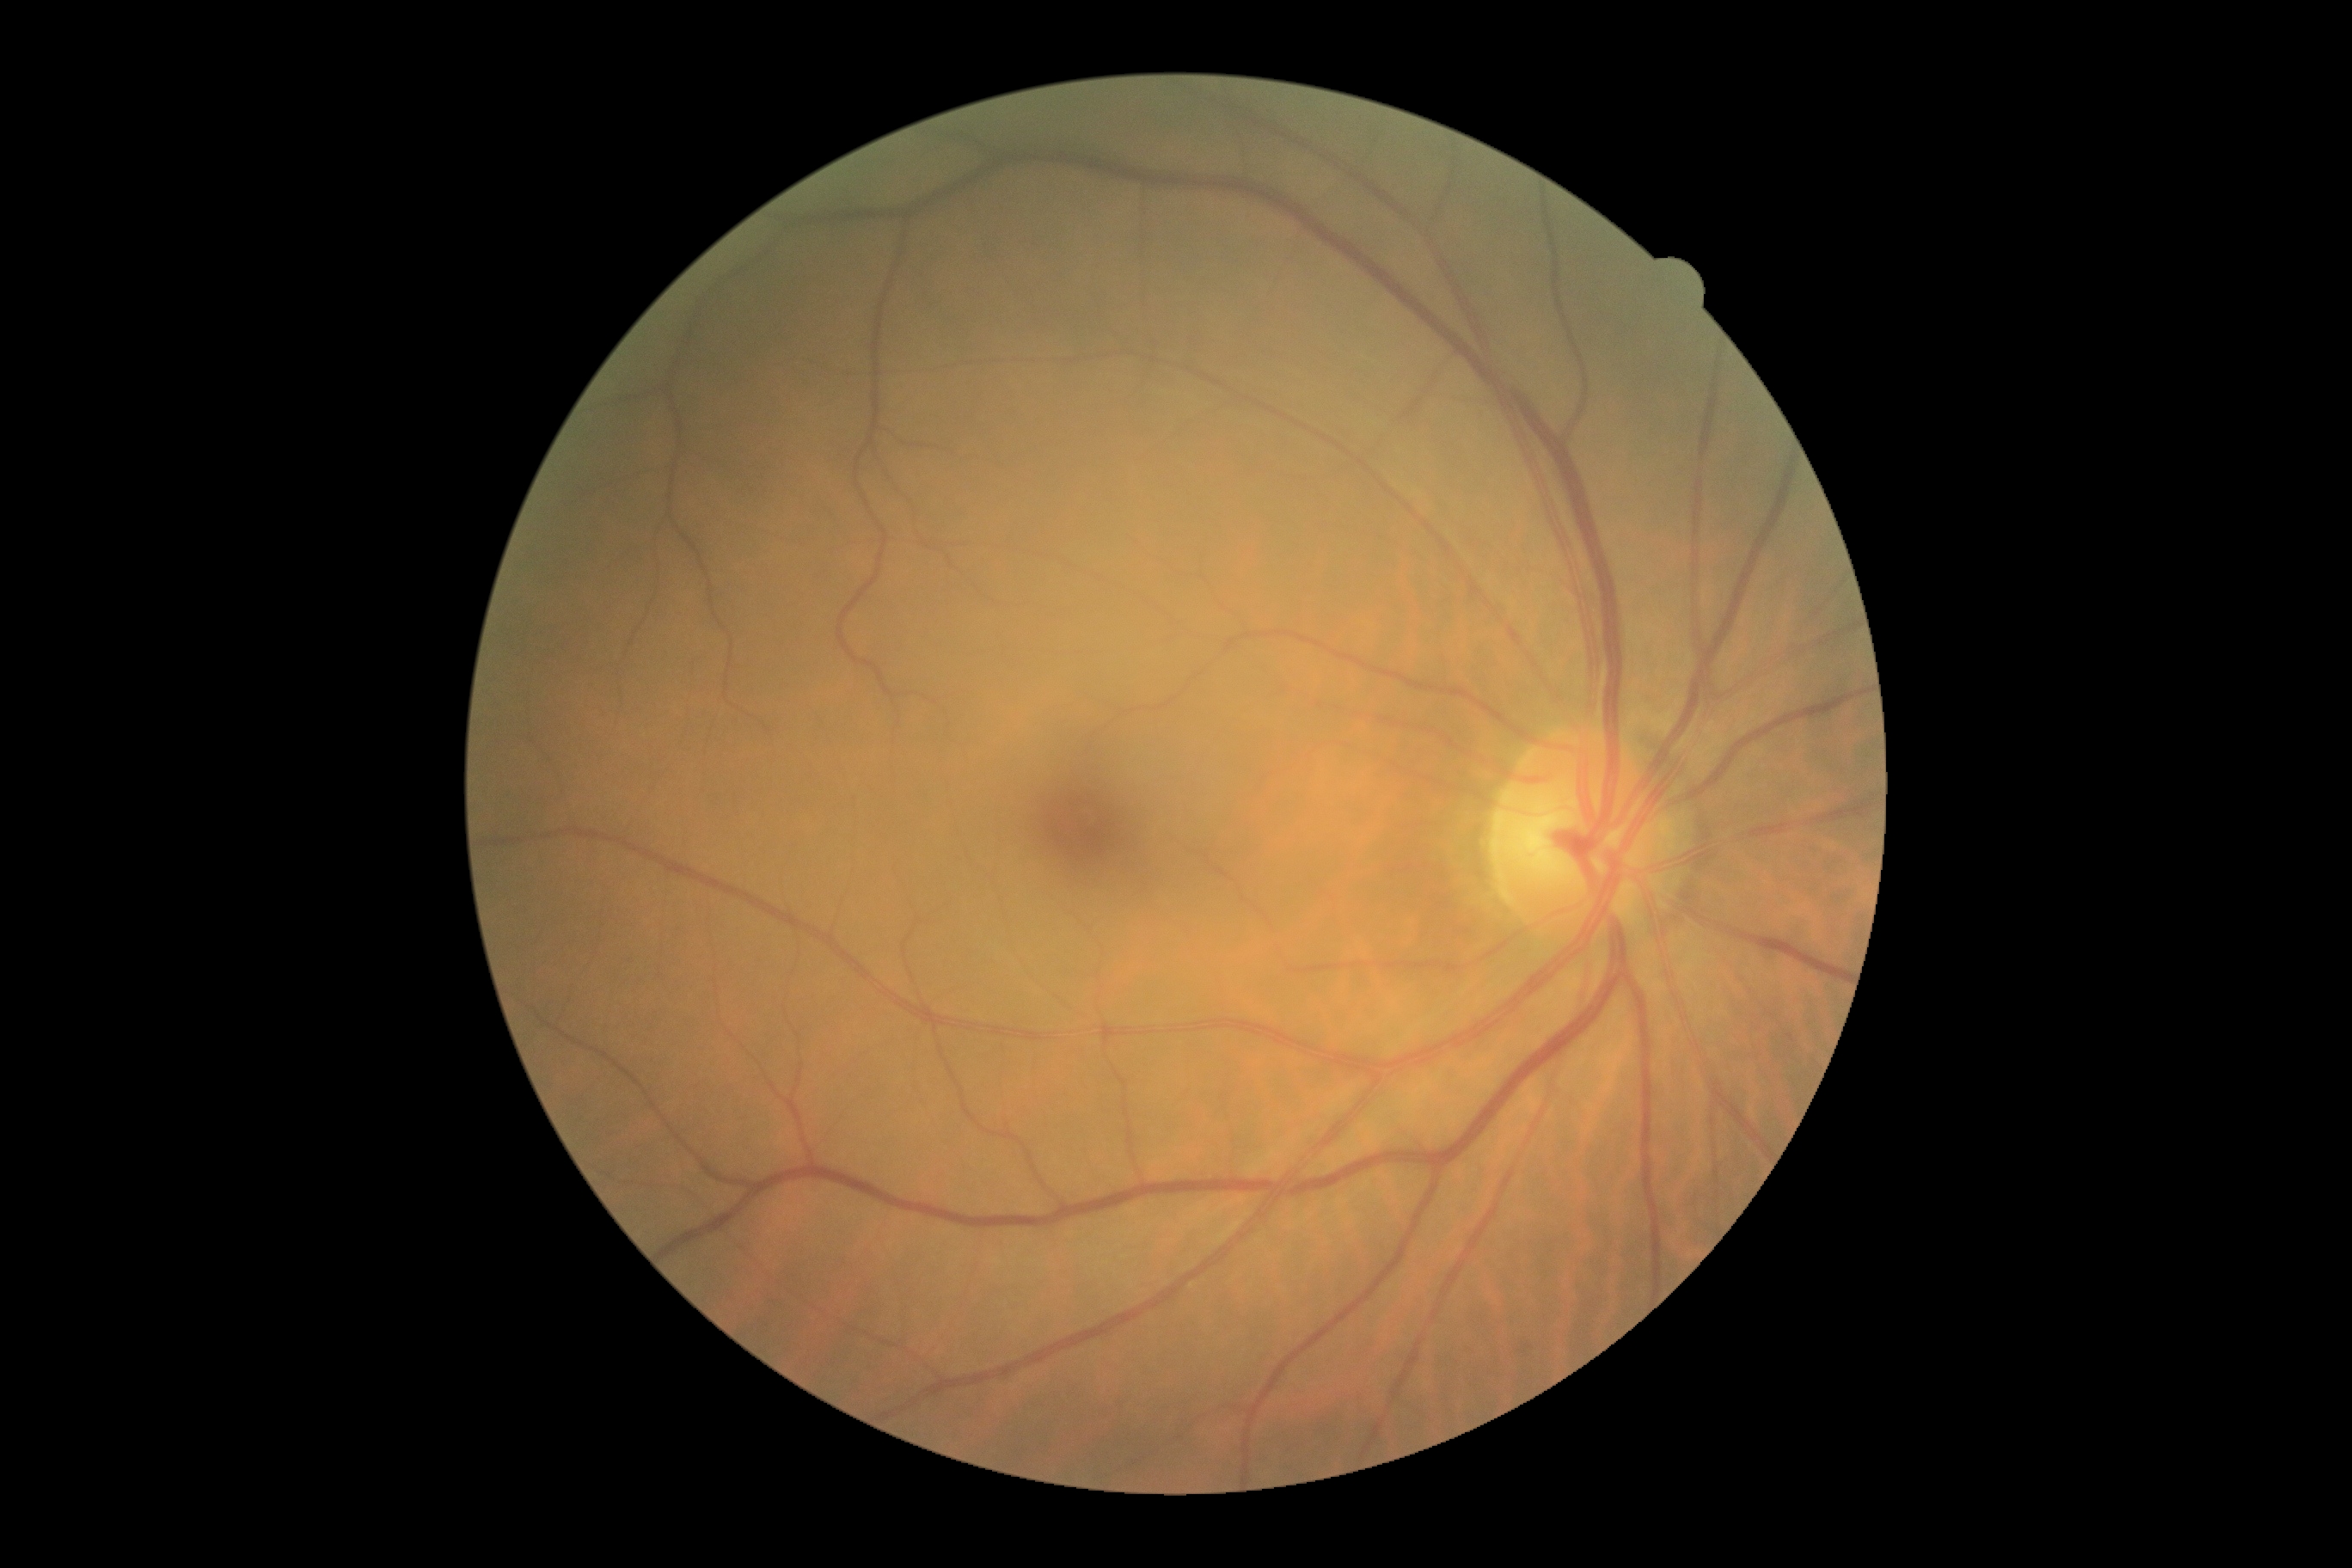 Diabetic retinopathy (DR): grade 0 (no apparent retinopathy) — no visible signs of diabetic retinopathy. No DR findings.